2352x1568.
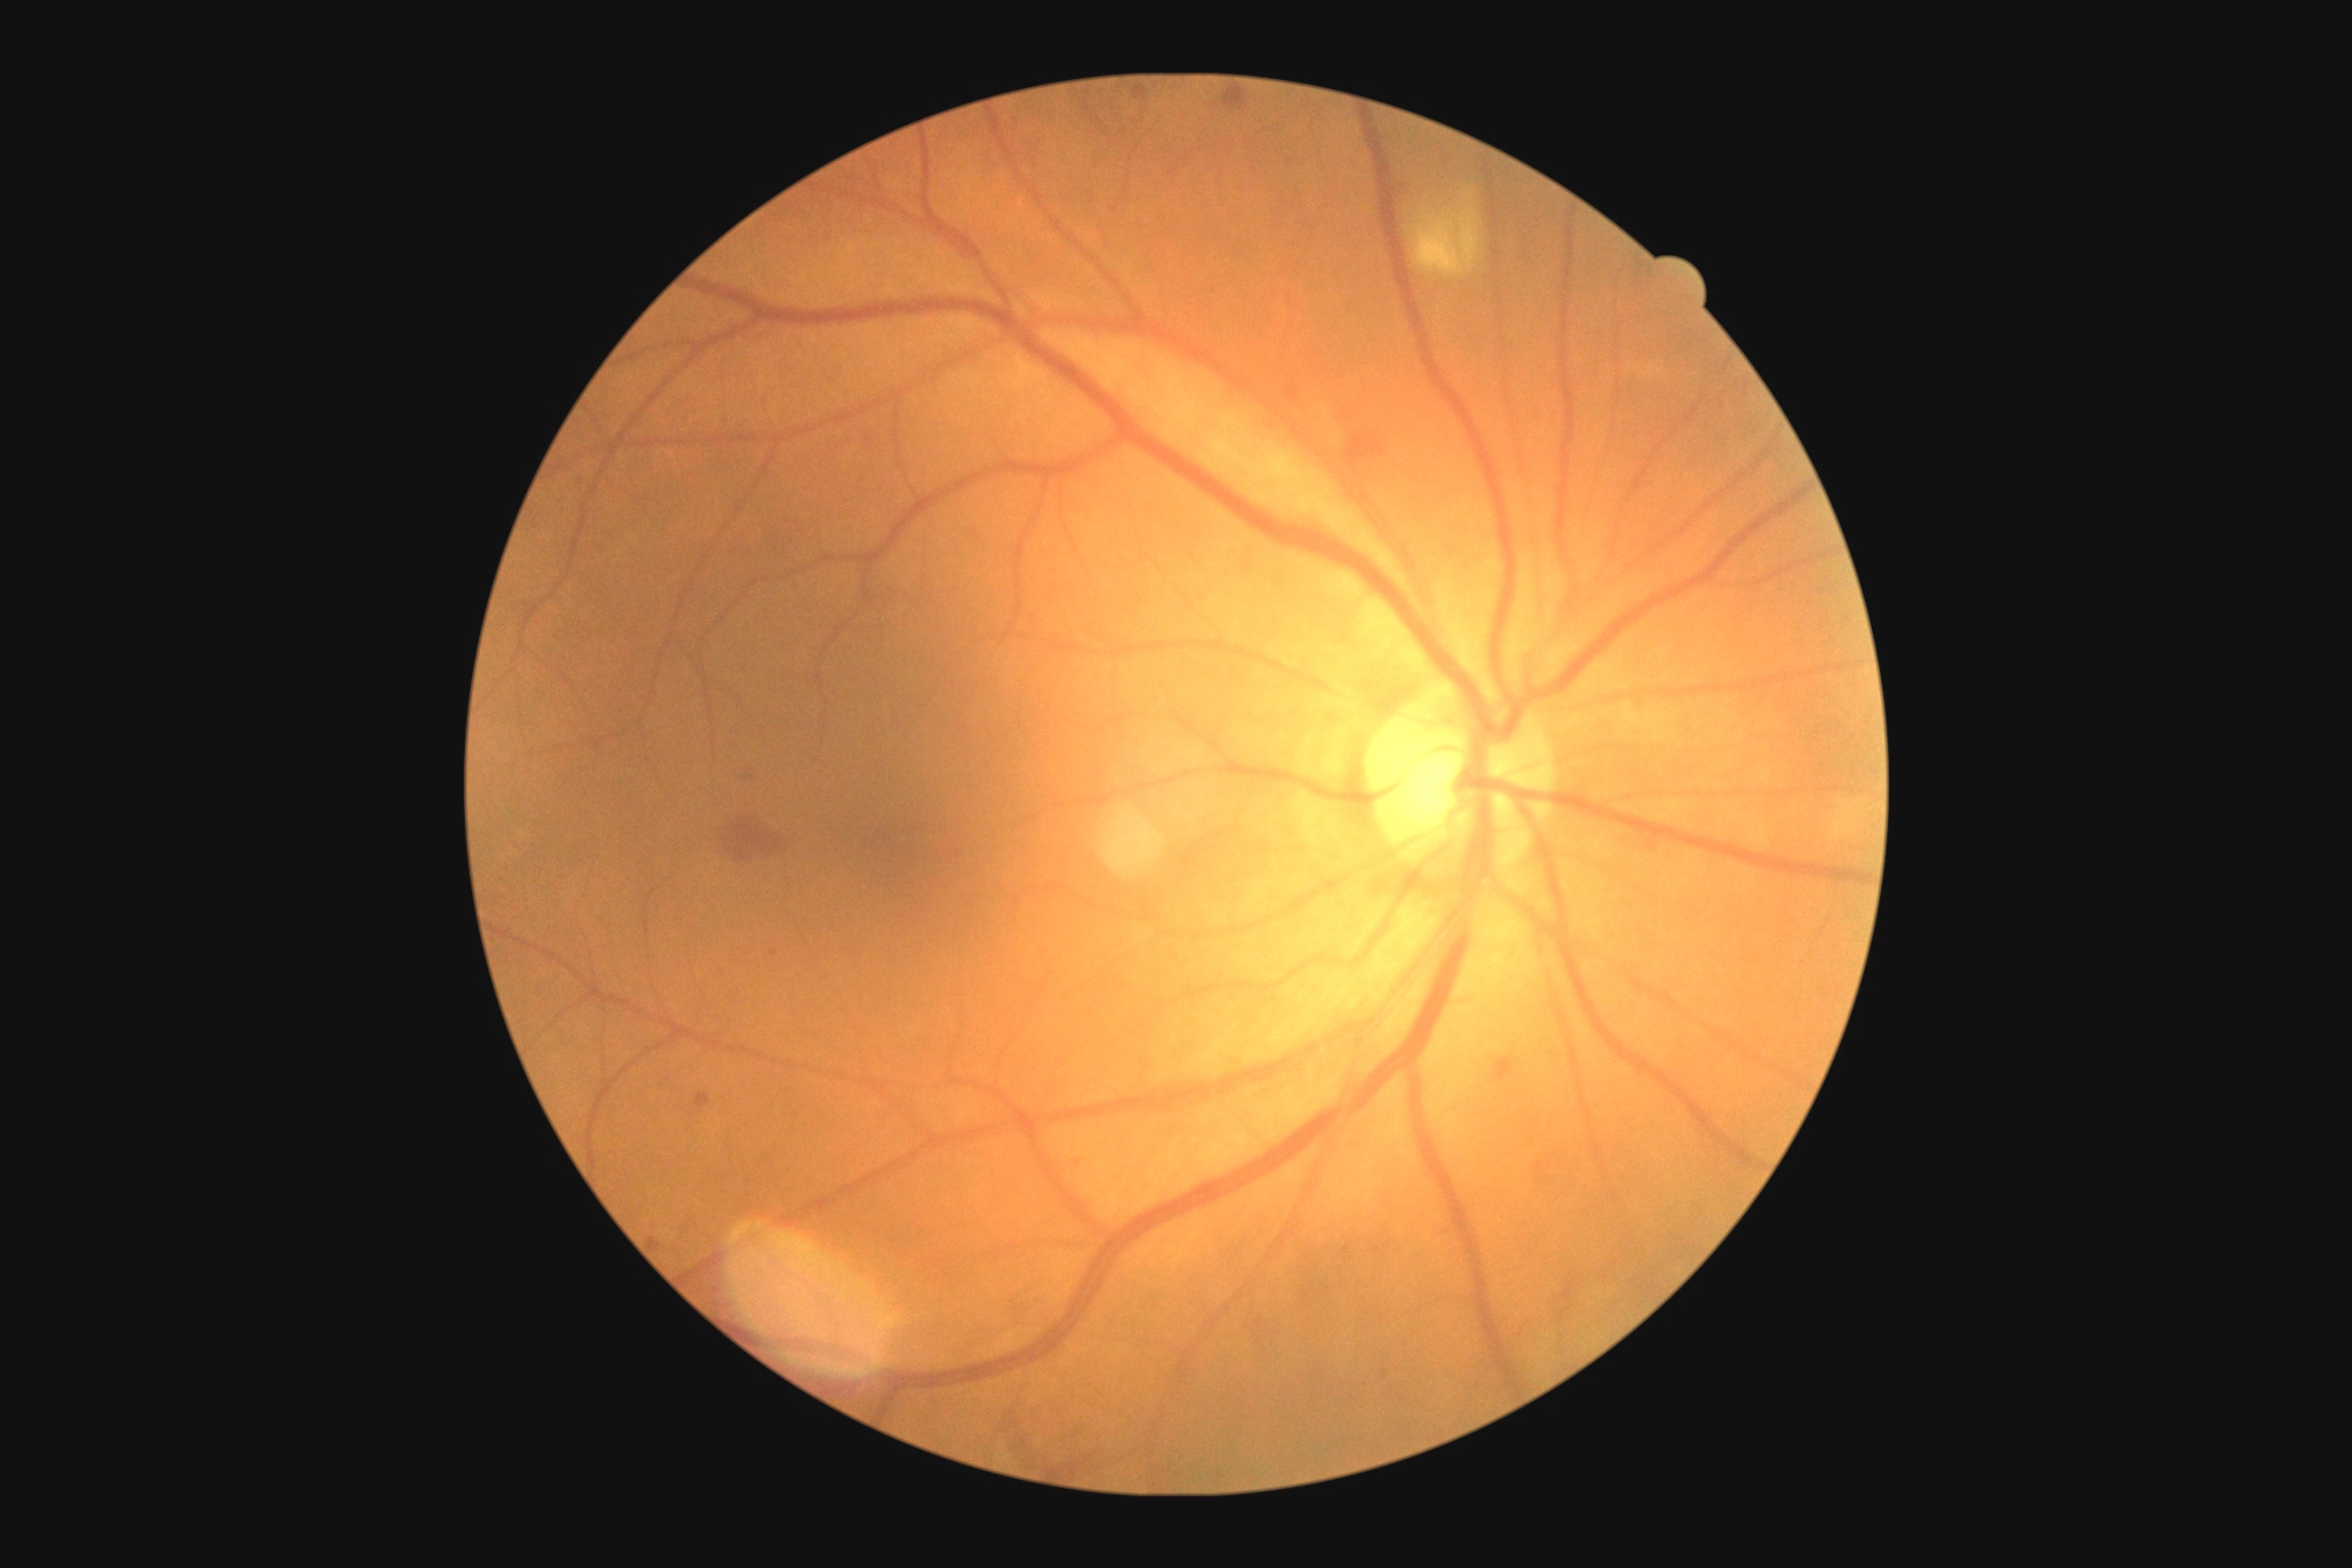 dr_grade: 2/4